2212x1659 · 45° FOV · color fundus photograph.
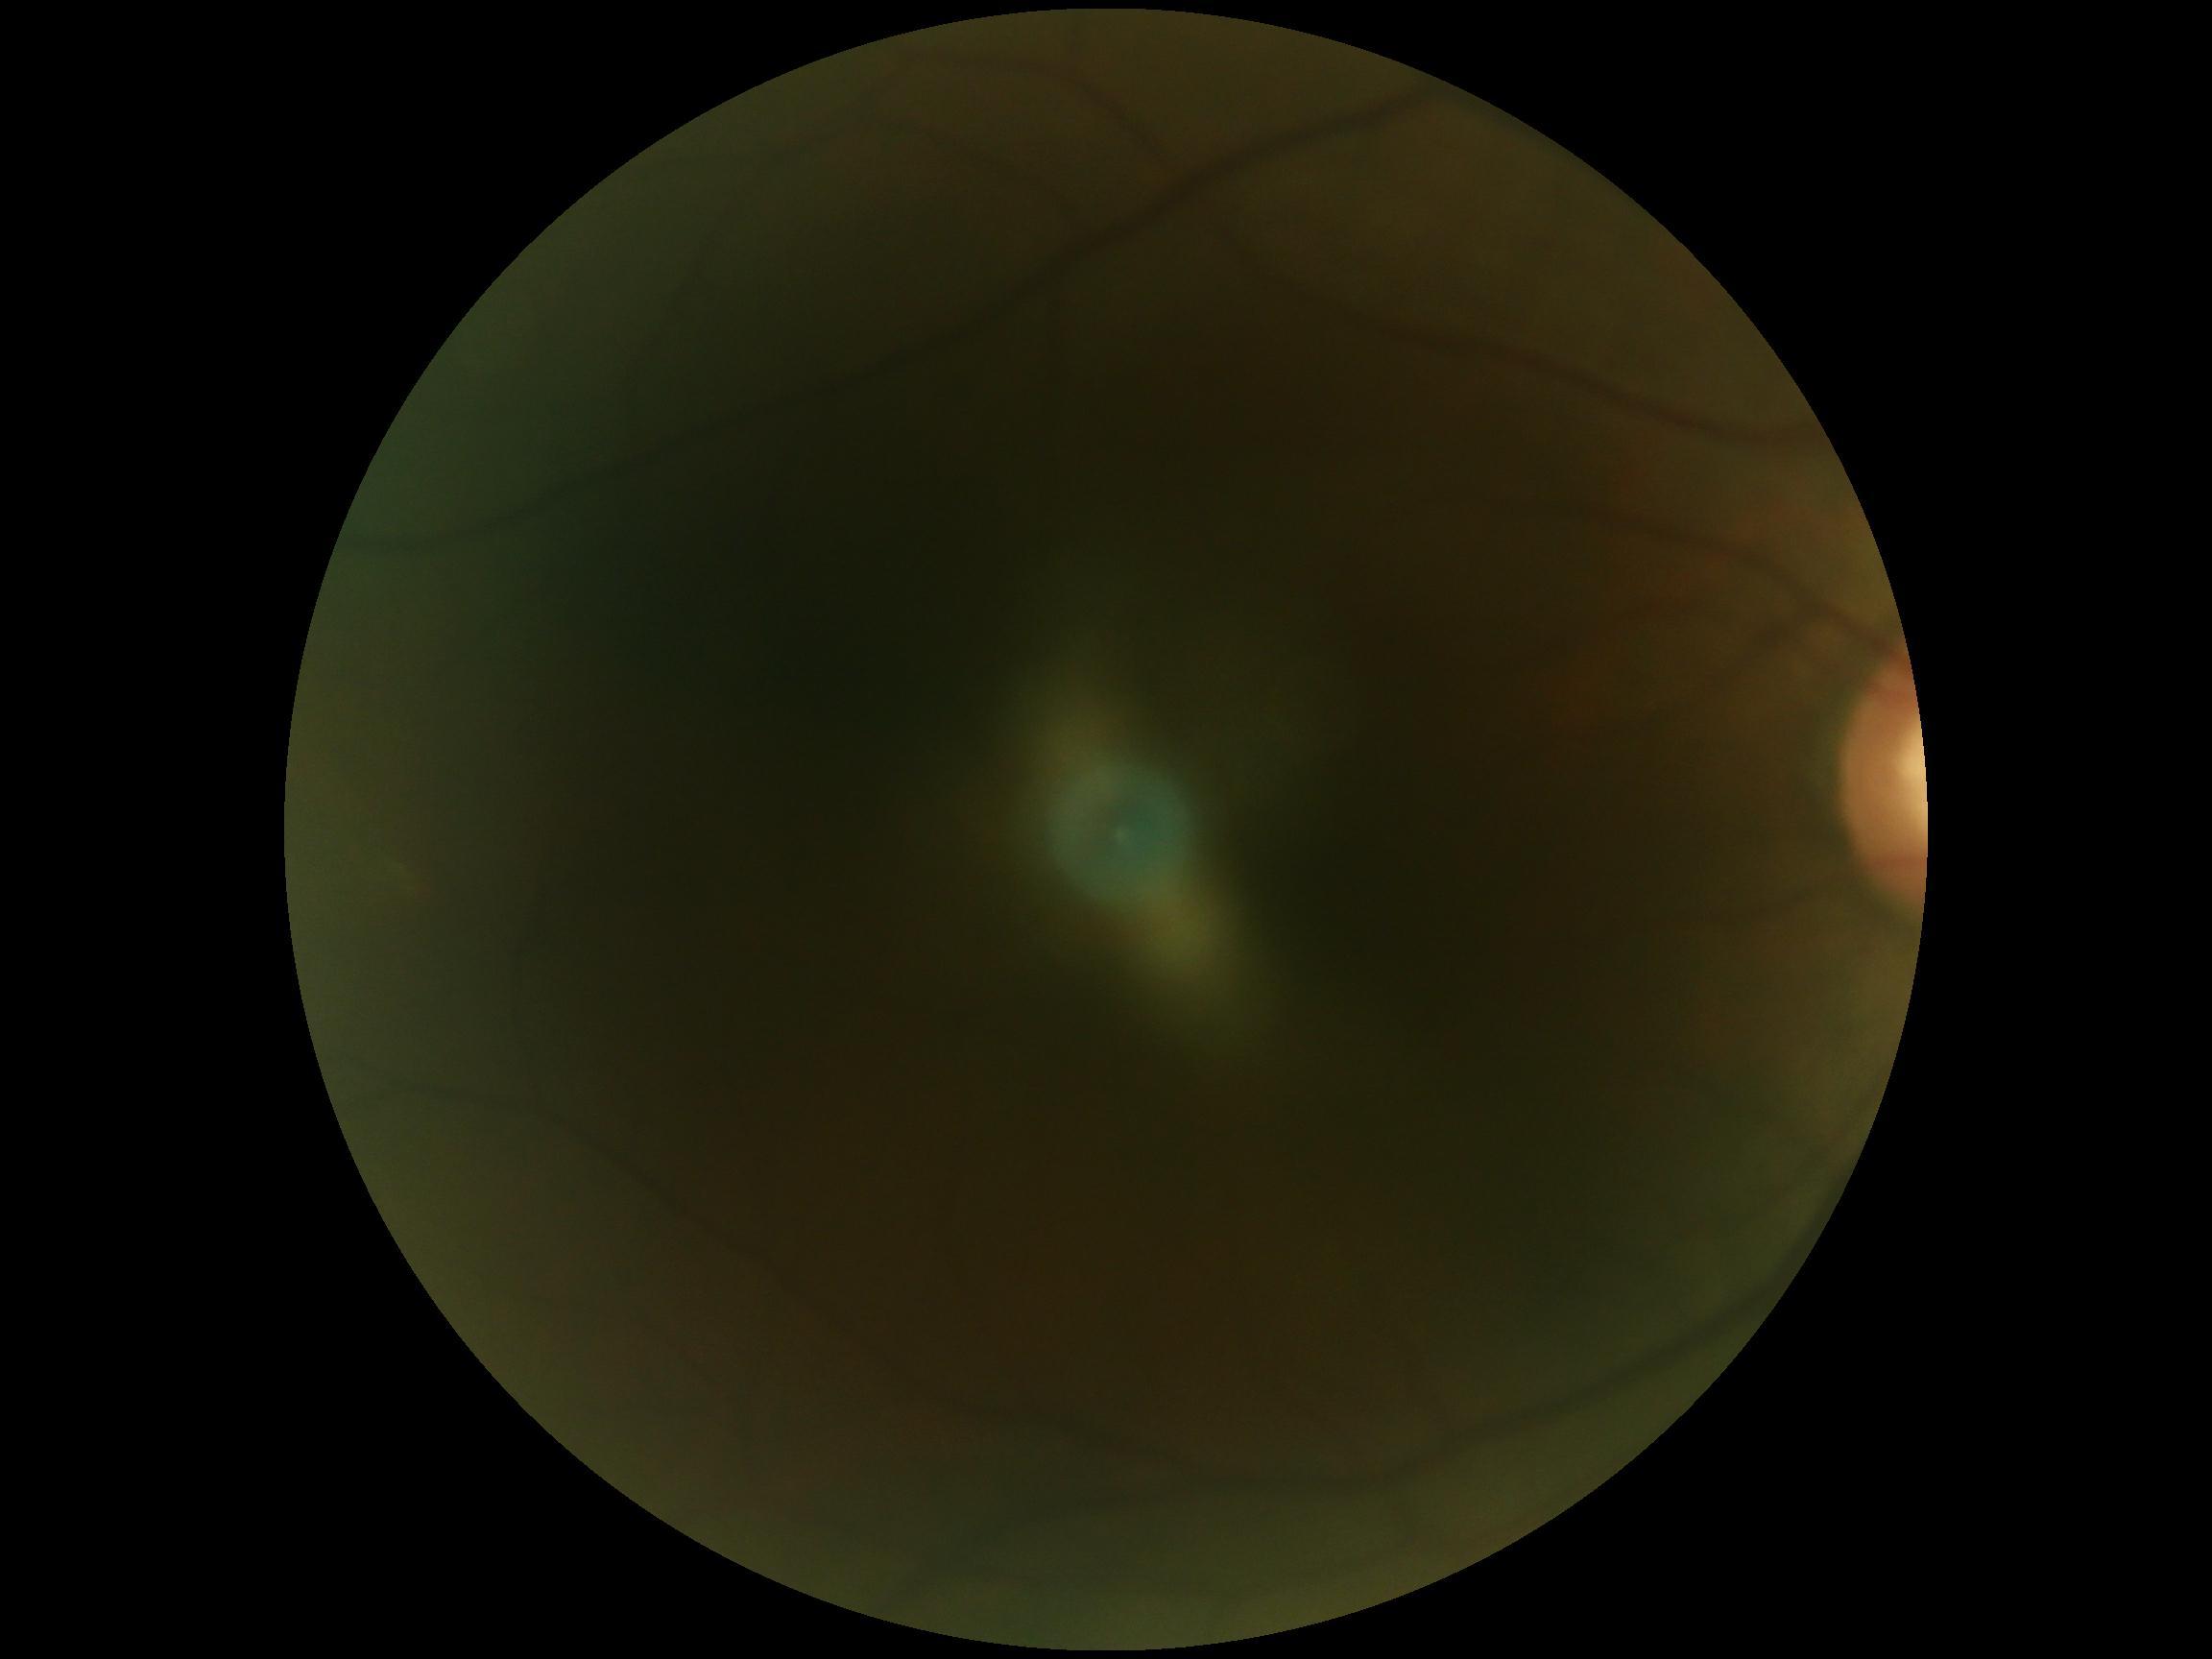

- image quality: below grading threshold
- DR stage: ungradable